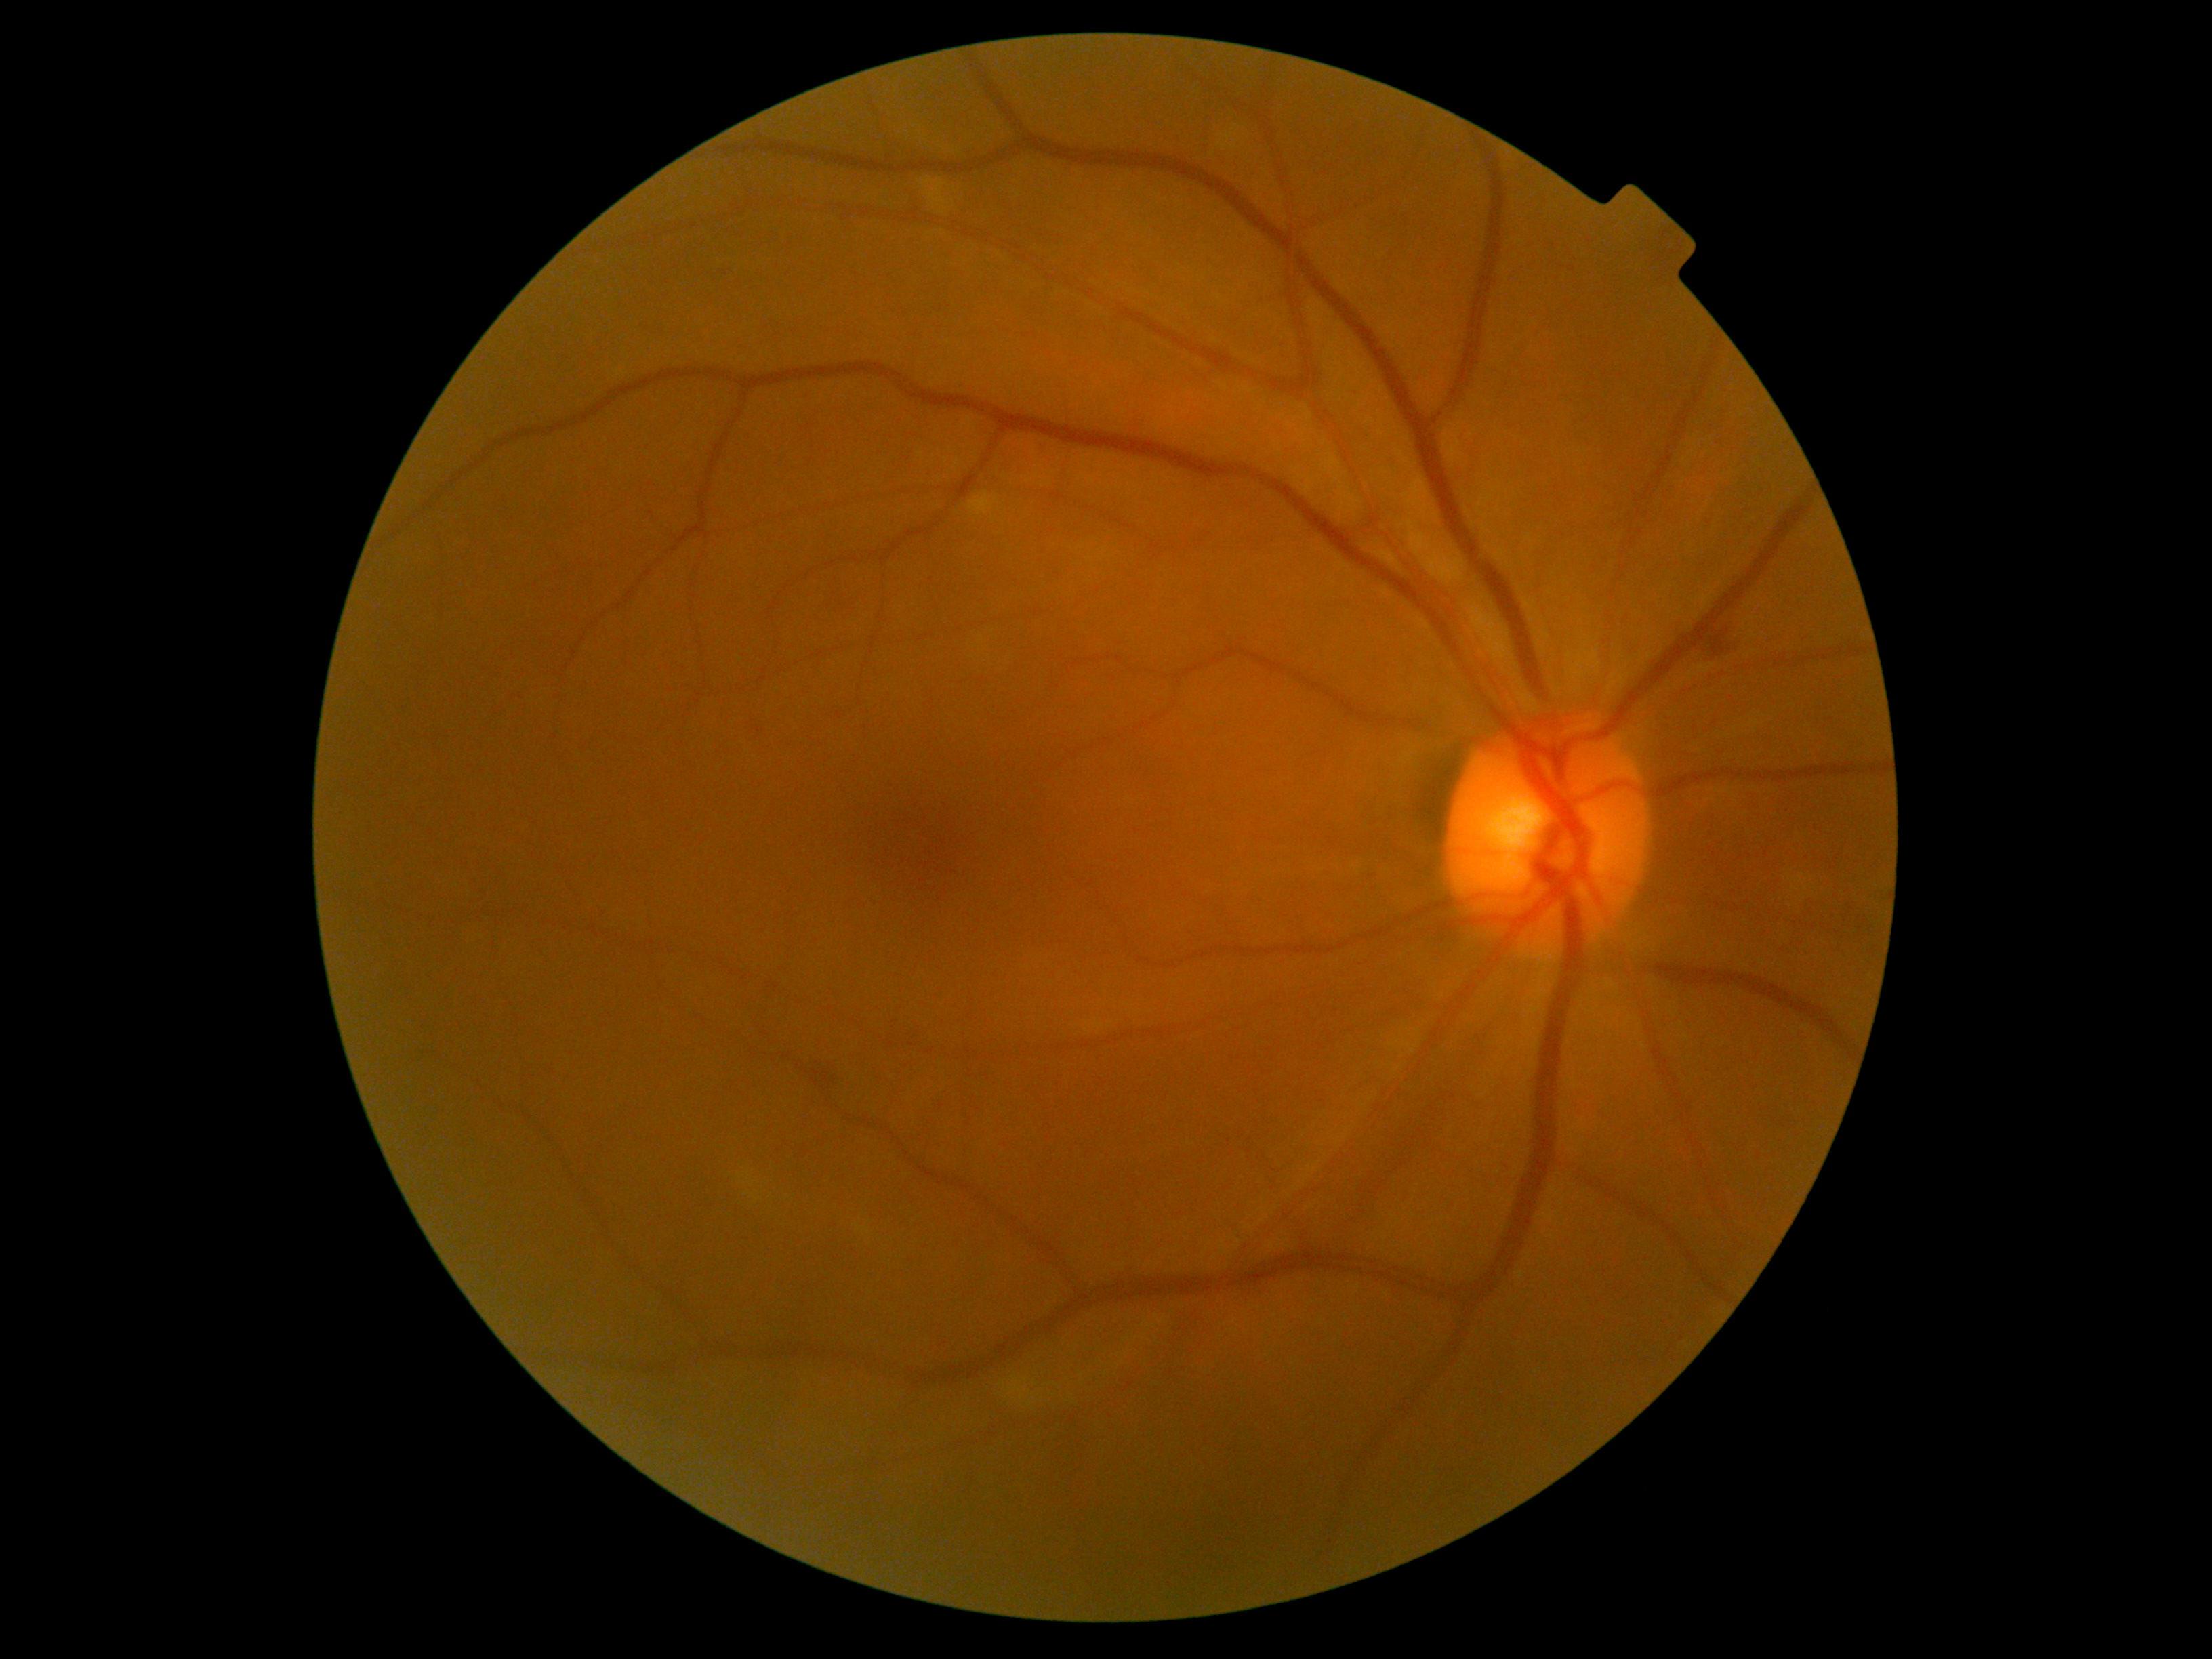 The retinopathy is classified as non-proliferative diabetic retinopathy. DR severity is grade 2 (moderate NPDR).